Retinal fundus photograph; 45° field of view; 2352x1568px — 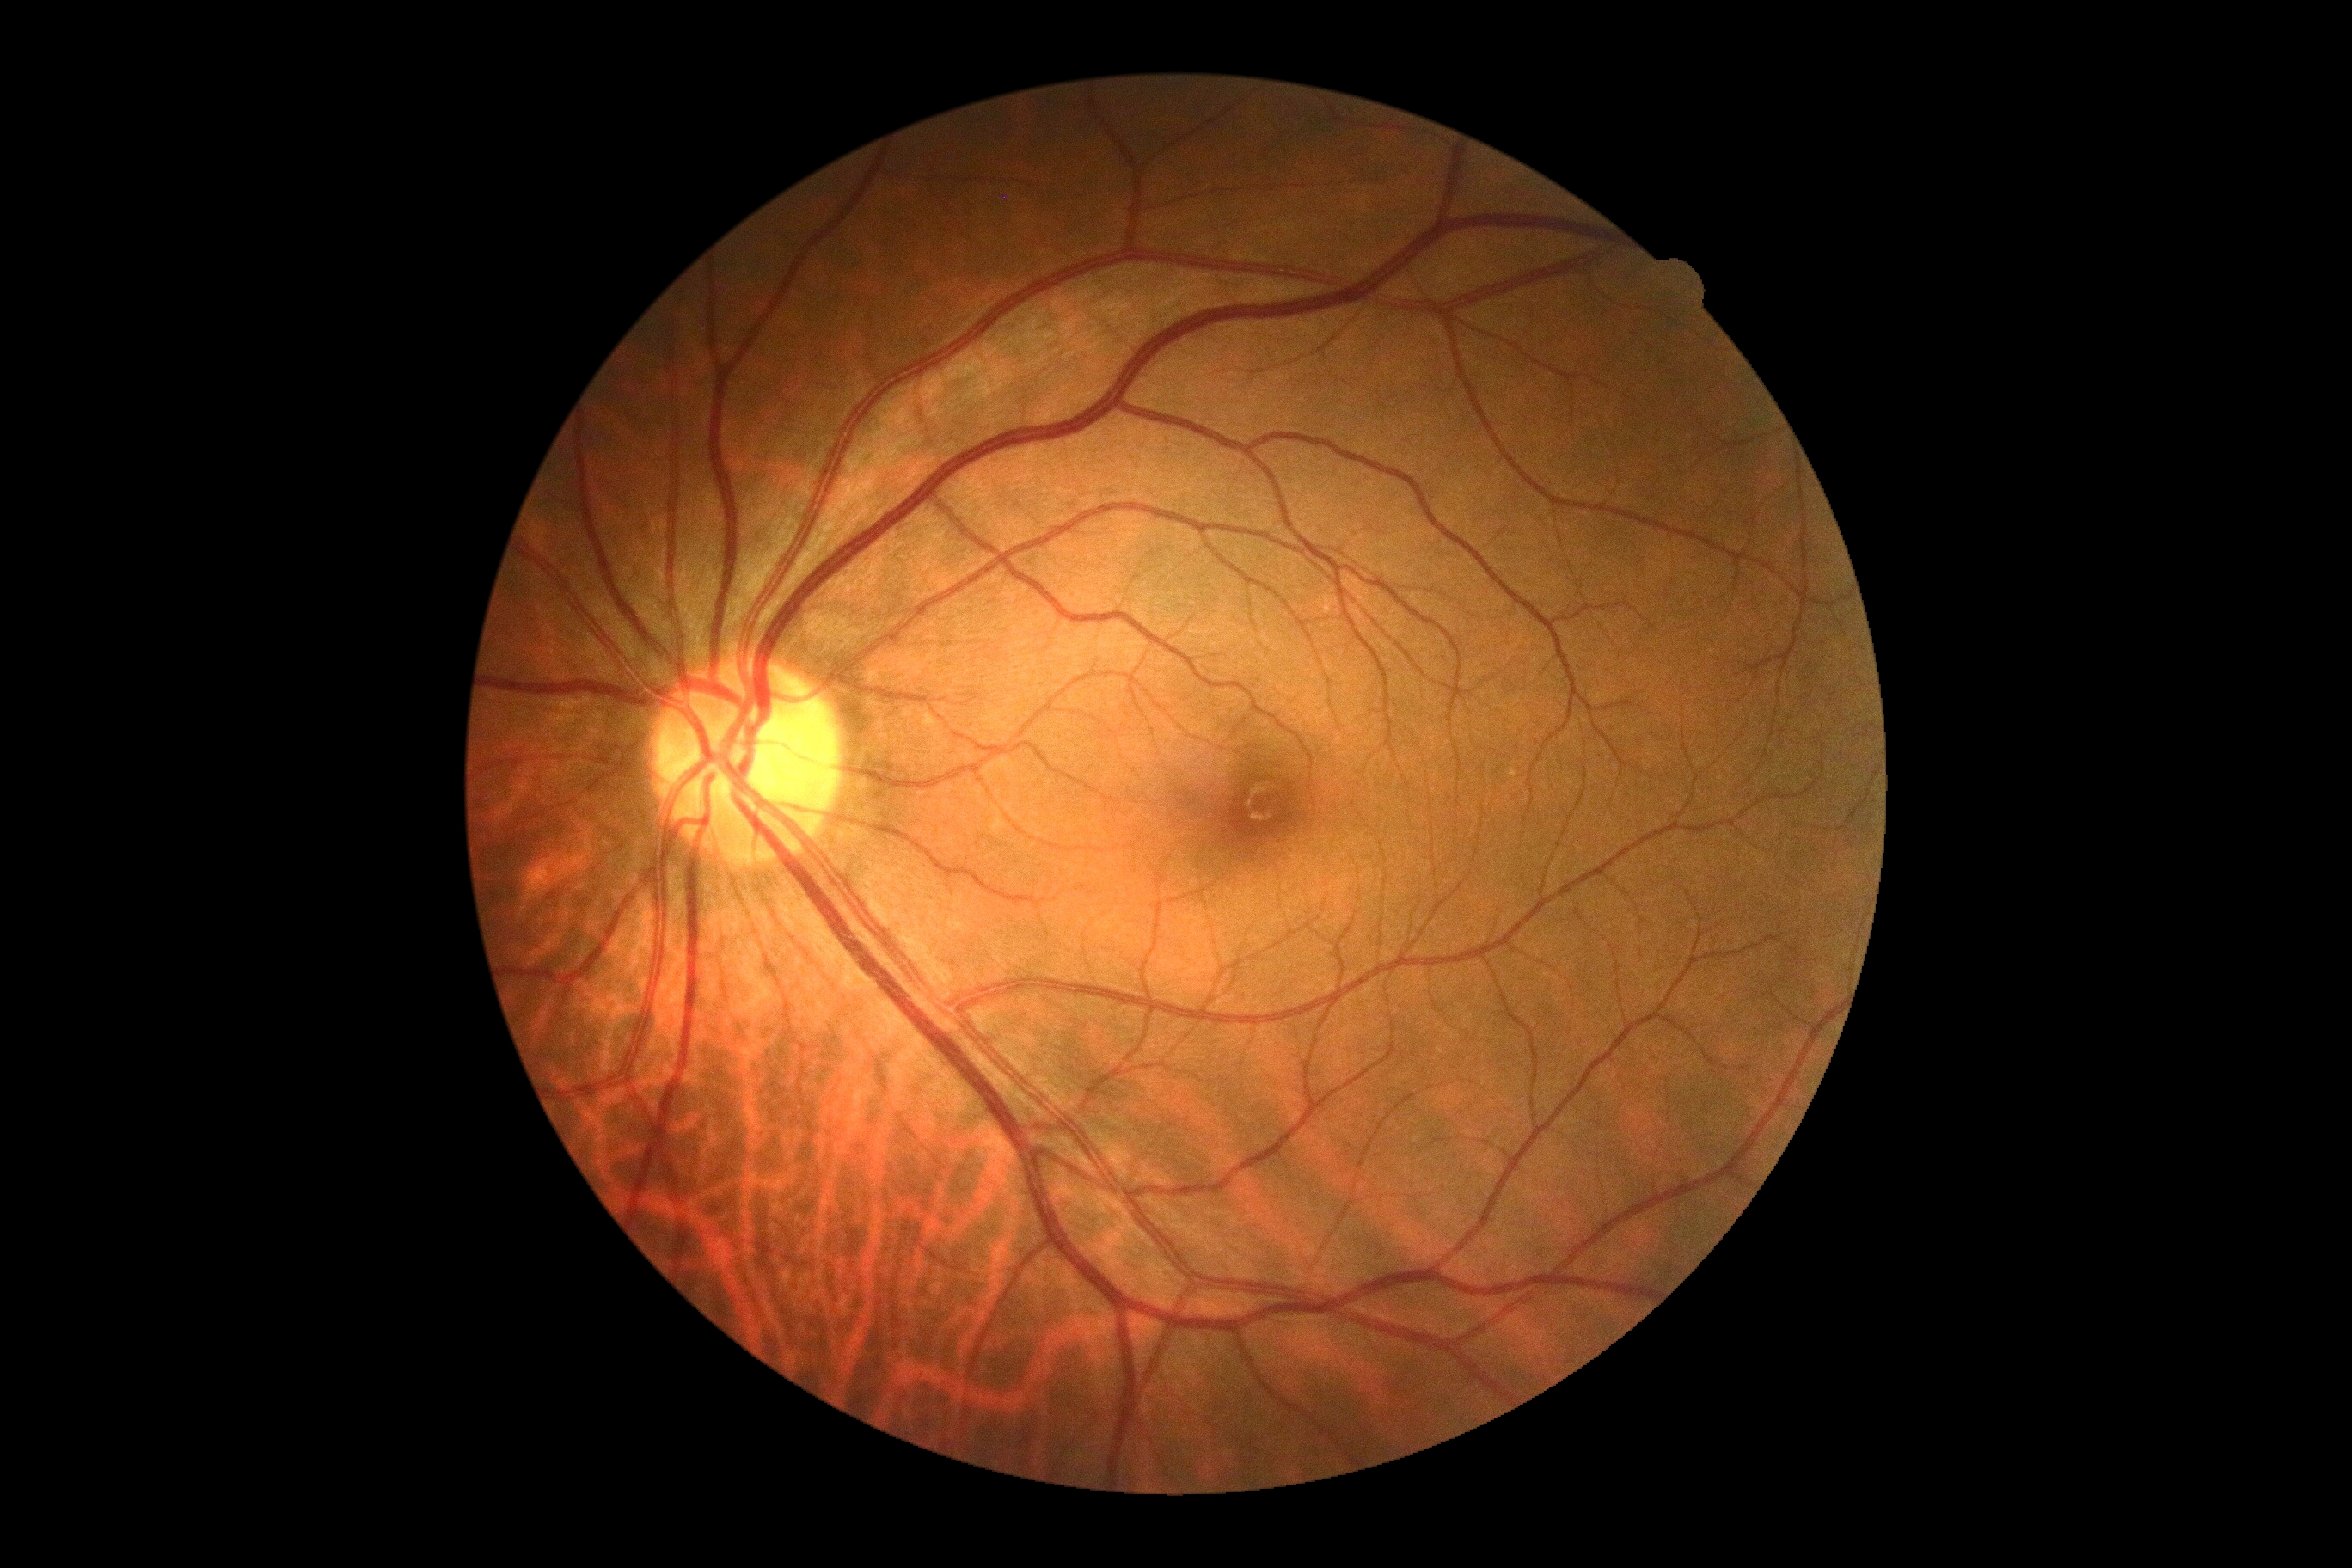
No signs of diabetic retinopathy. DR severity: grade 0 (no apparent retinopathy).